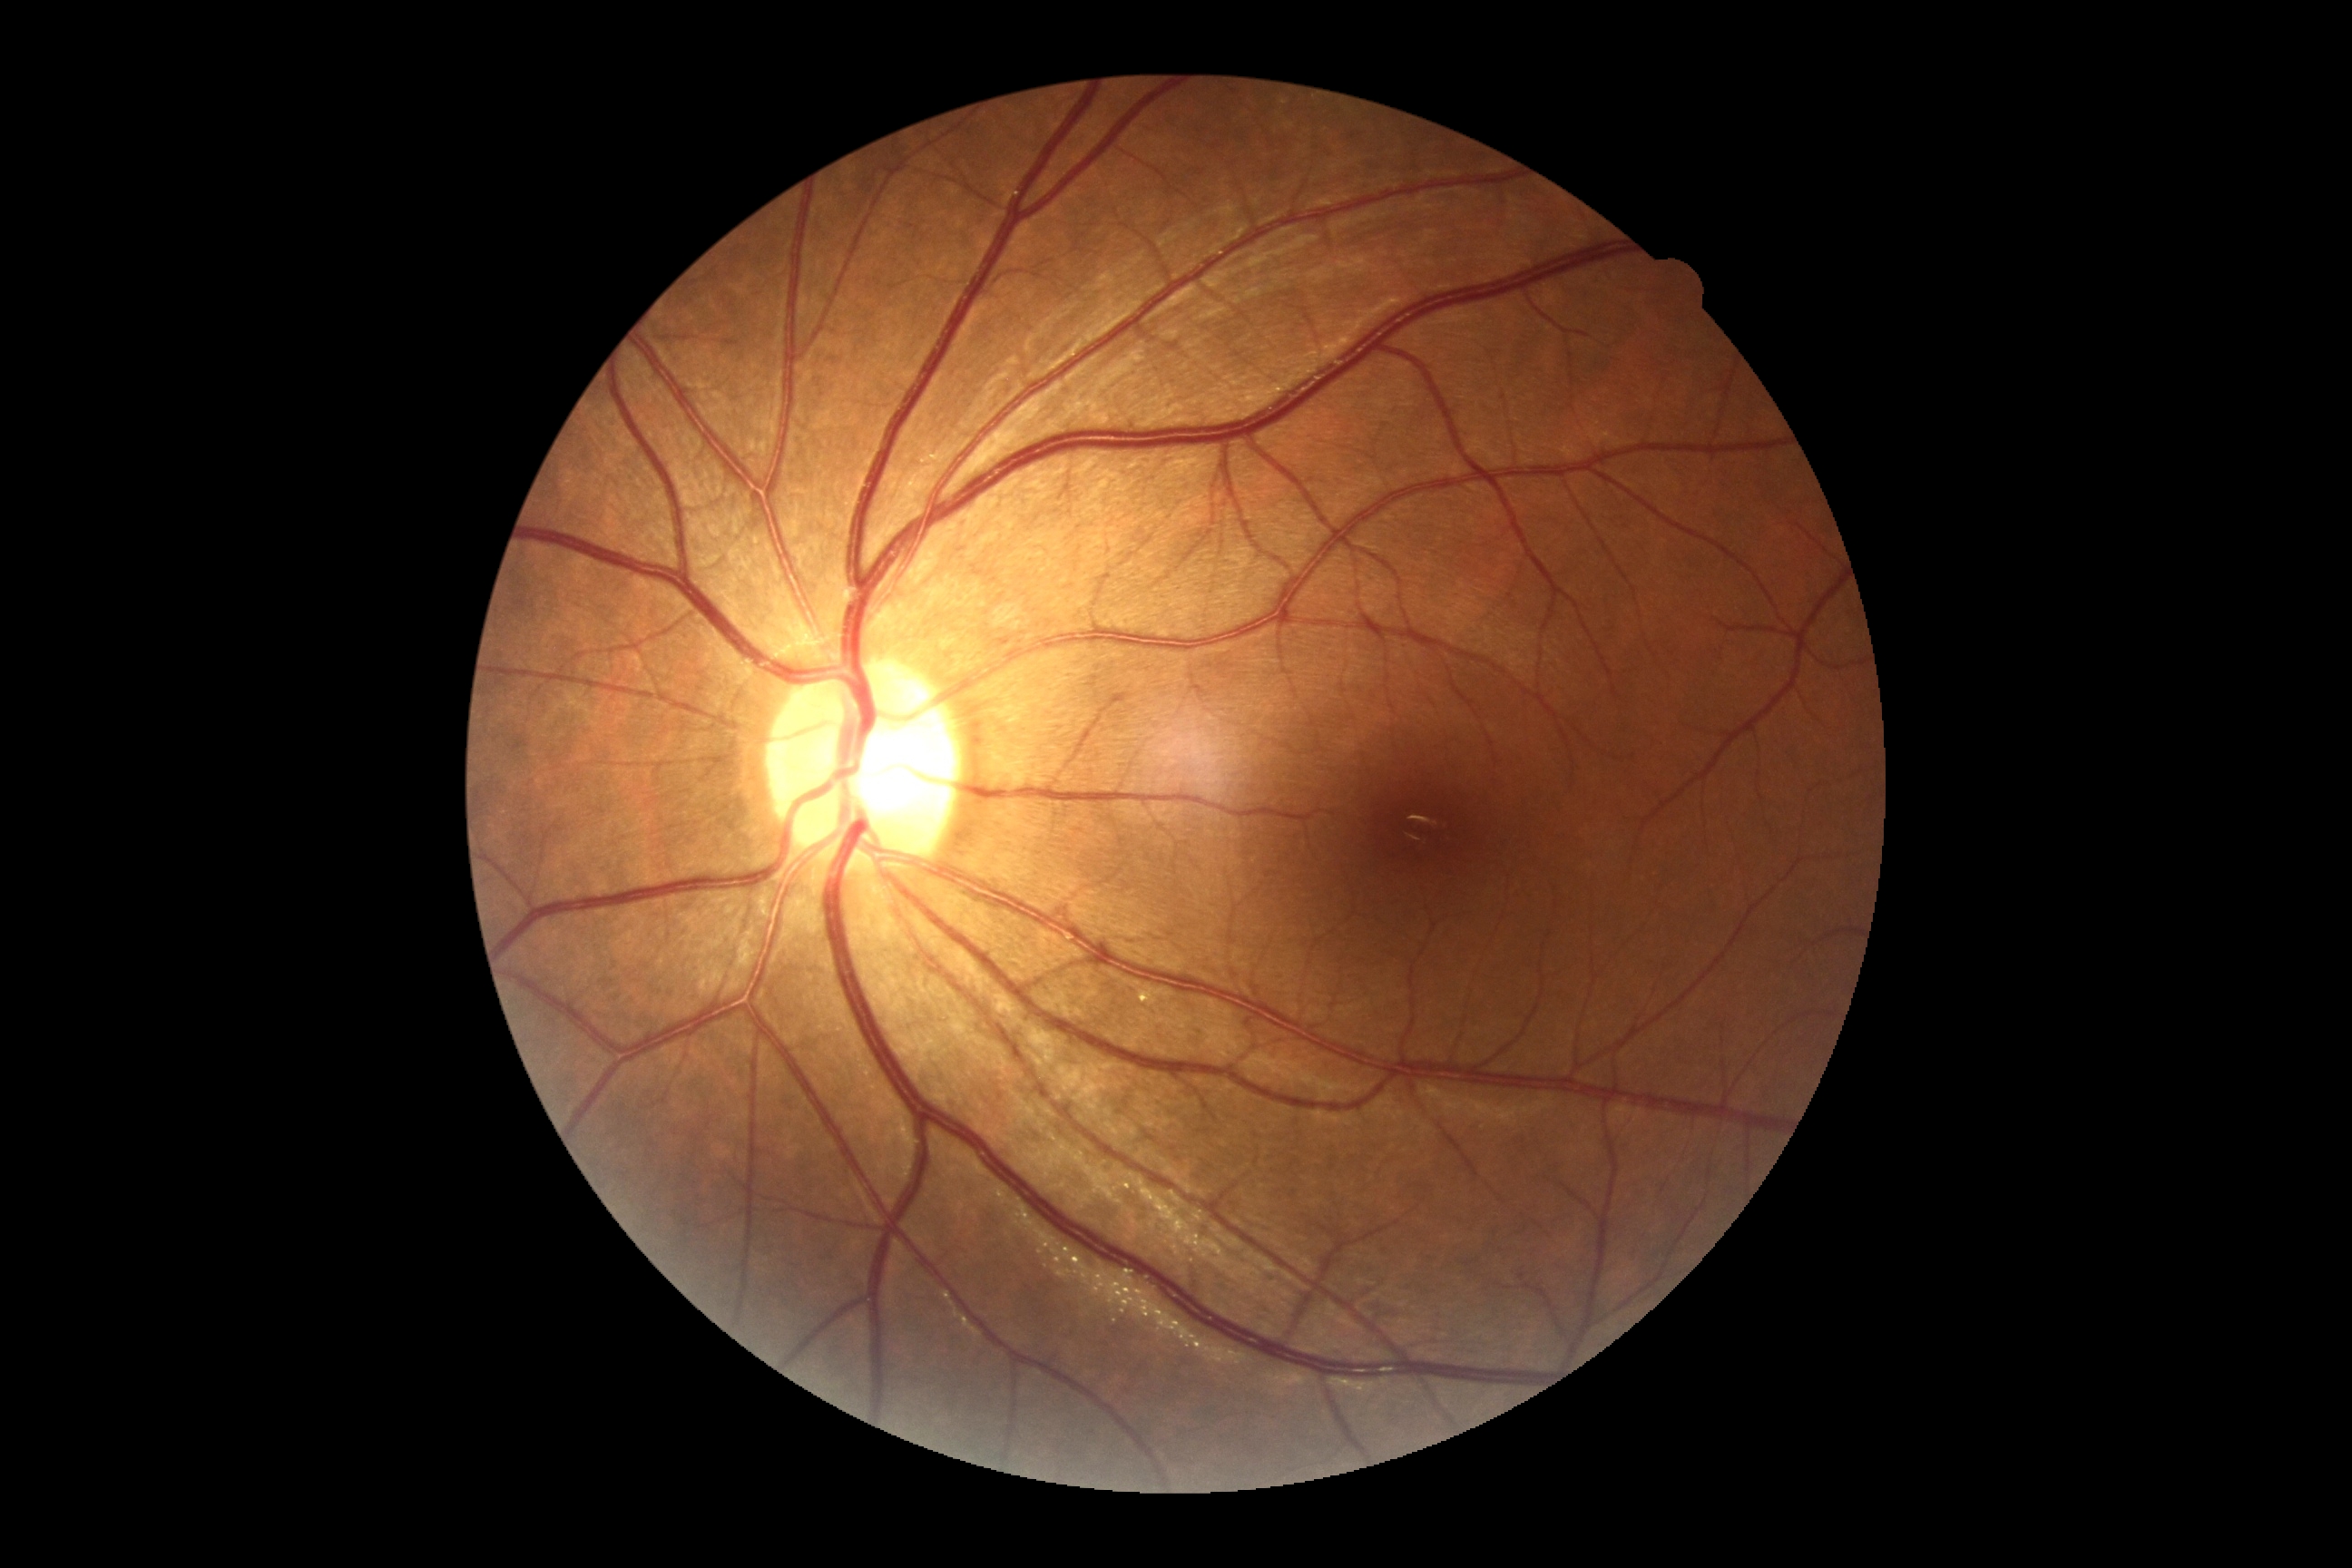
Retinopathy grade is no apparent retinopathy (0).